2212x1659, CFP, 45° field of view — 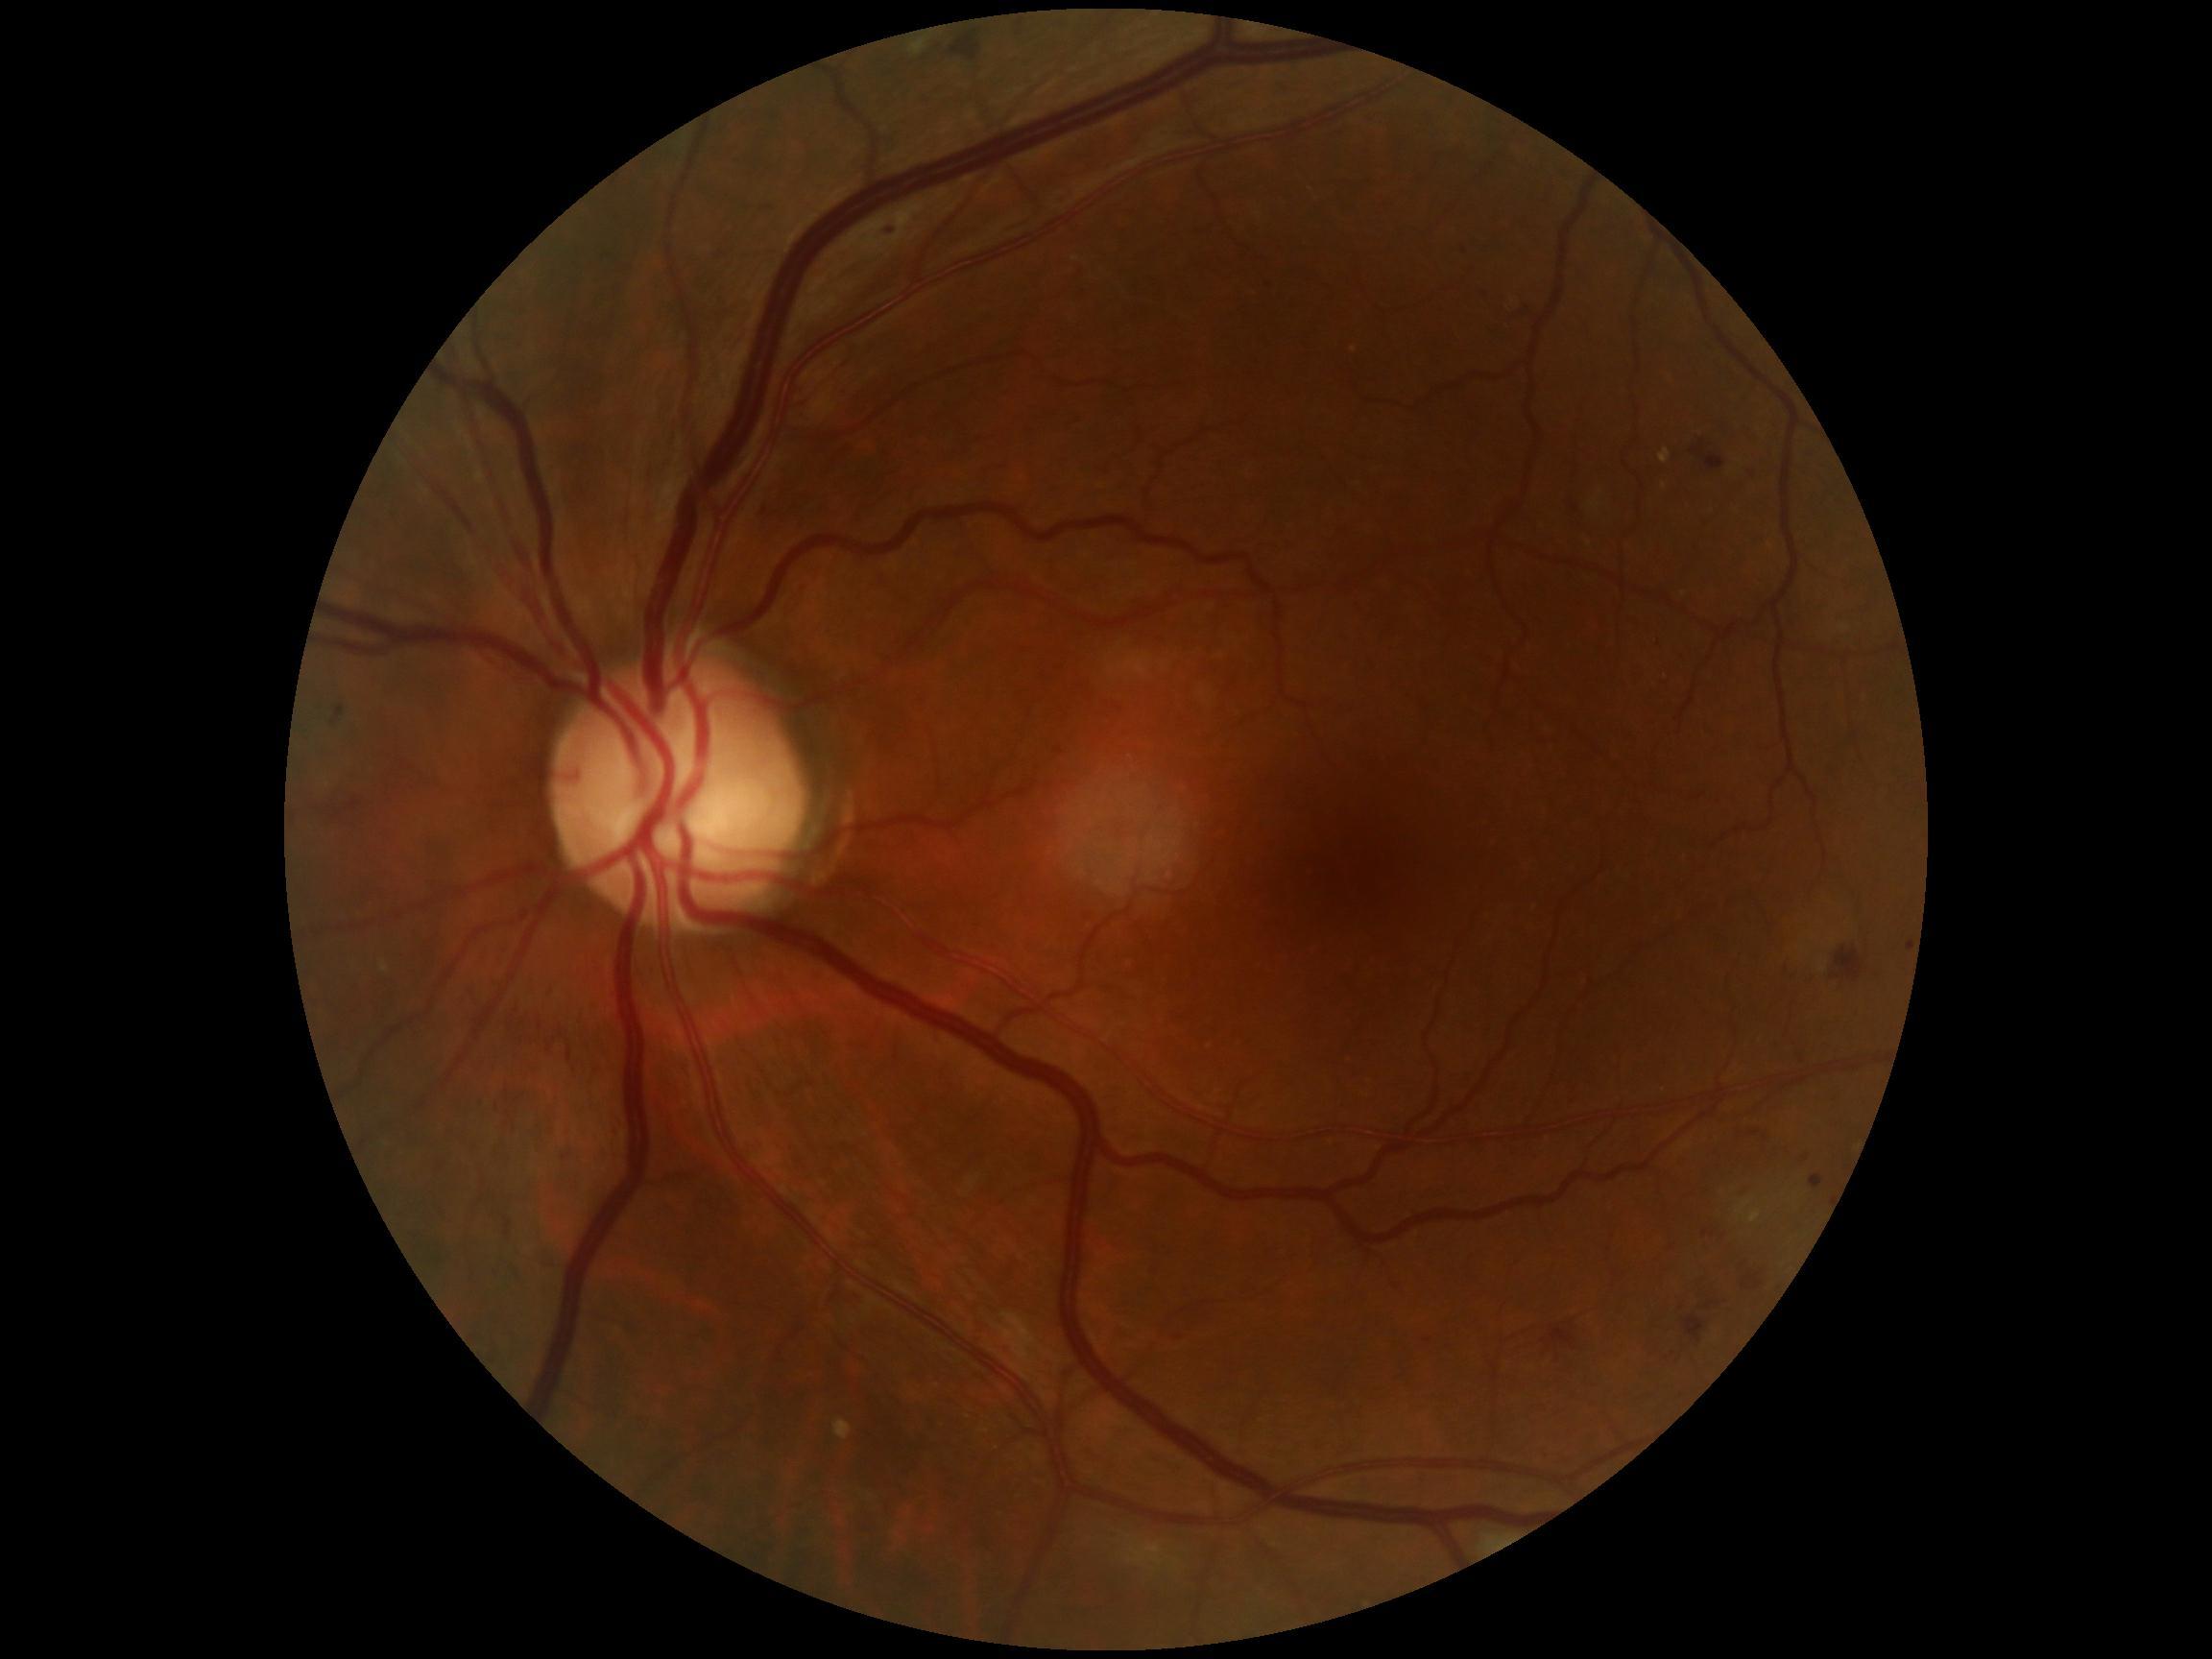
  dr_grade: 2